45° FOV; retinal fundus photograph.
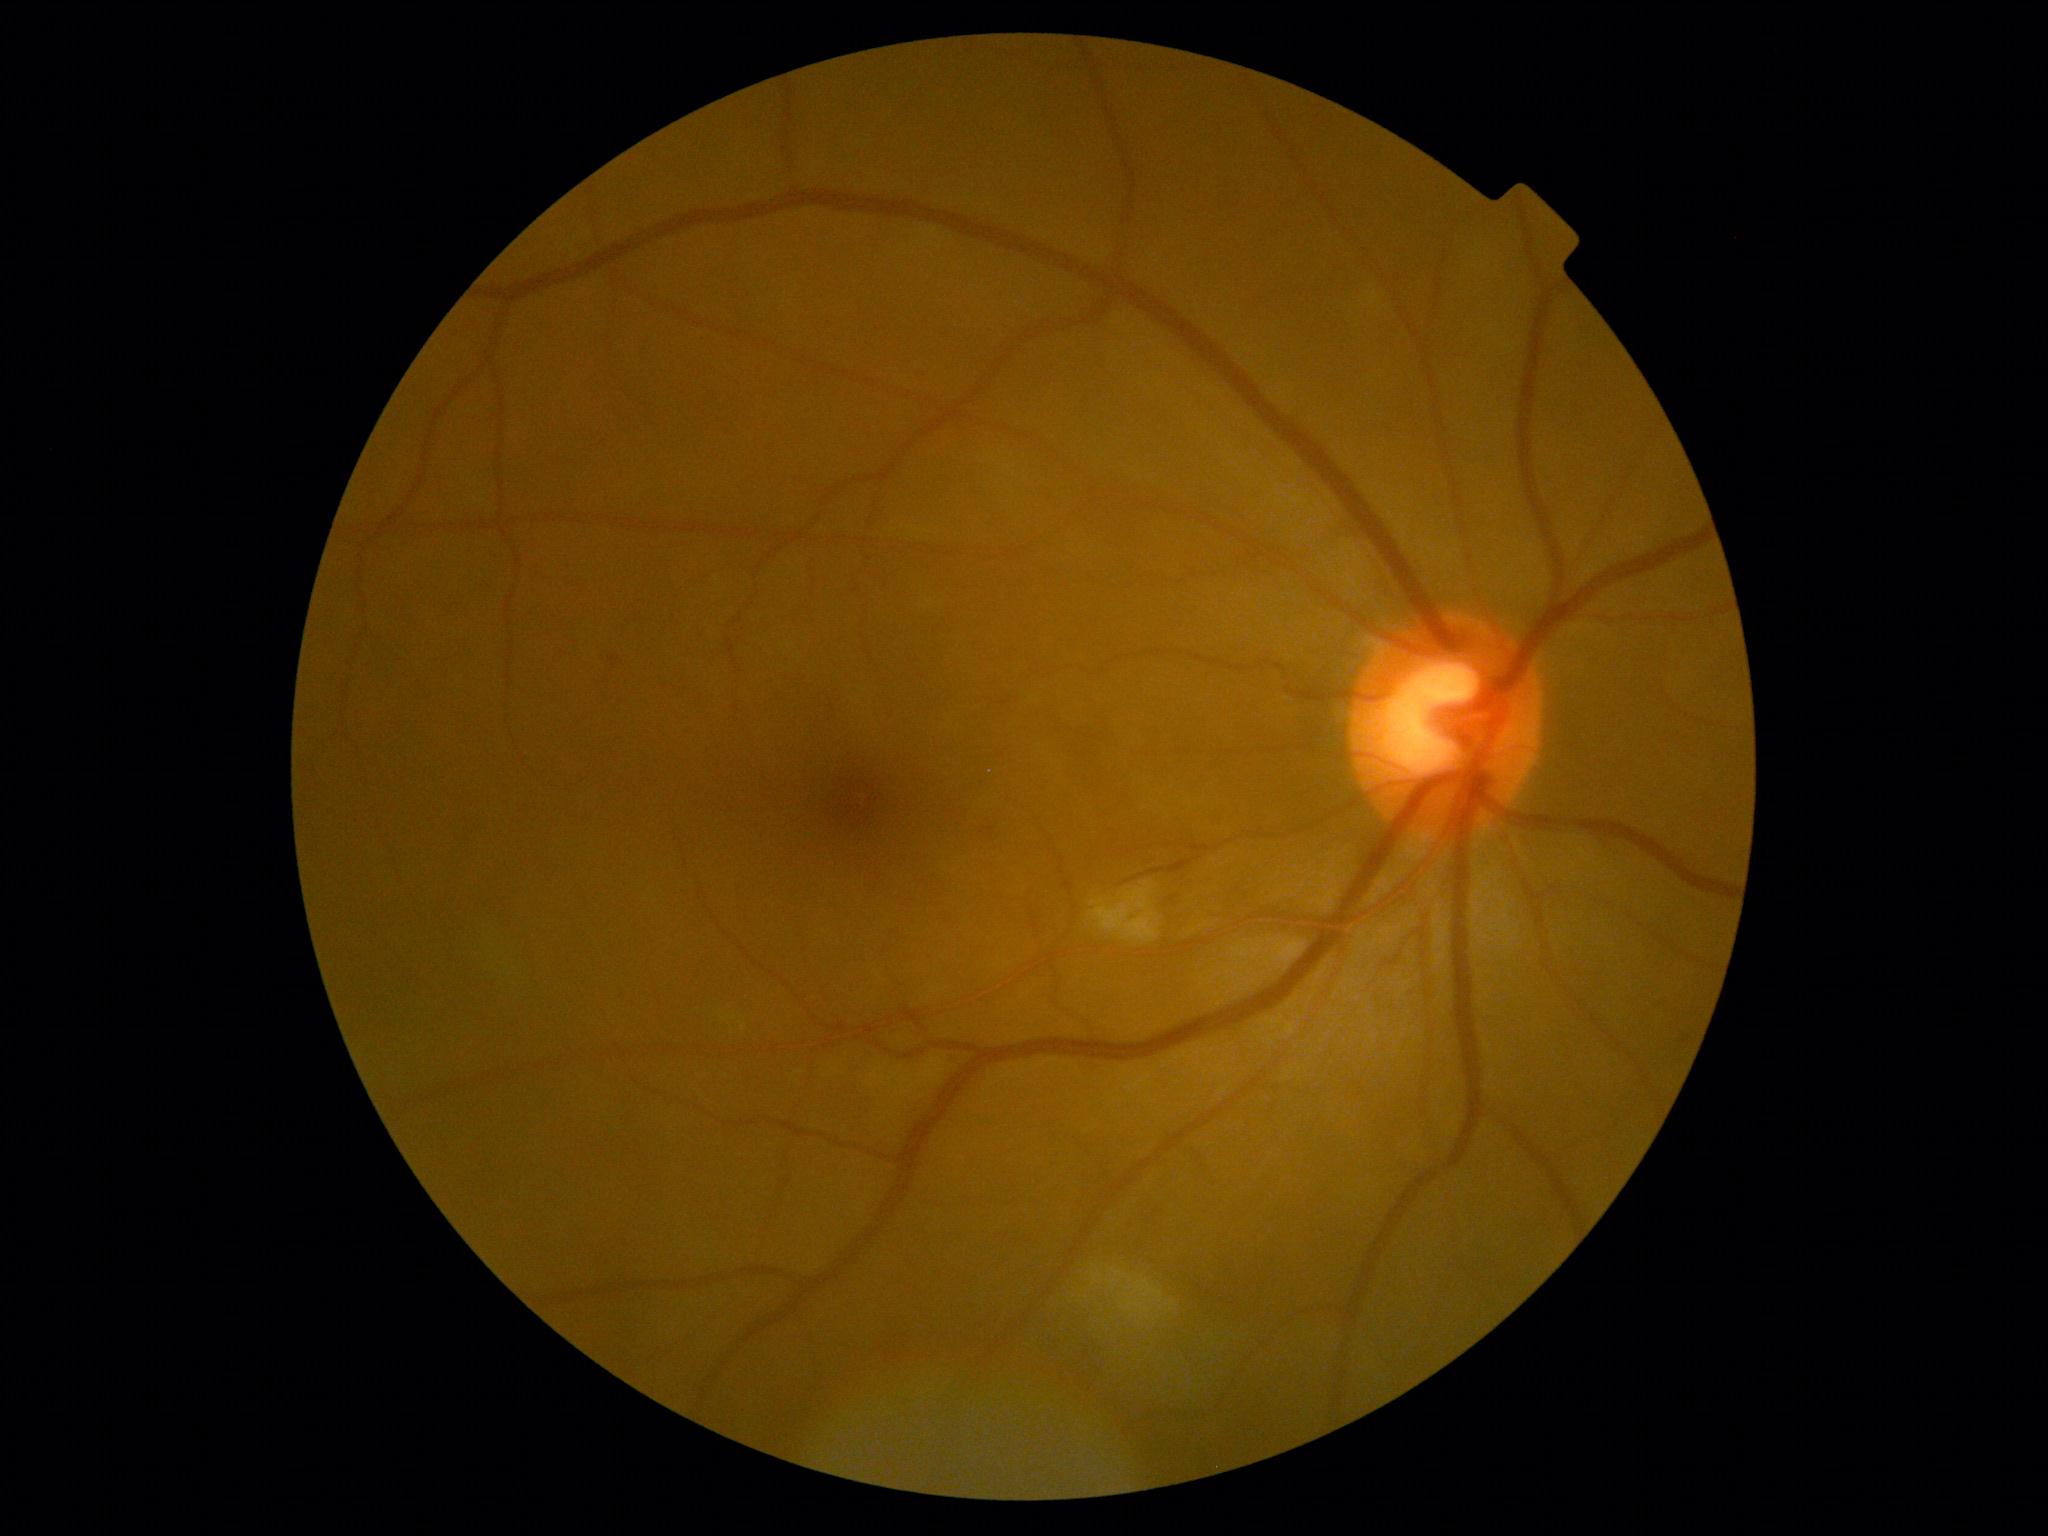

Findings:
- DR stage — 2/4